Davis DR grading
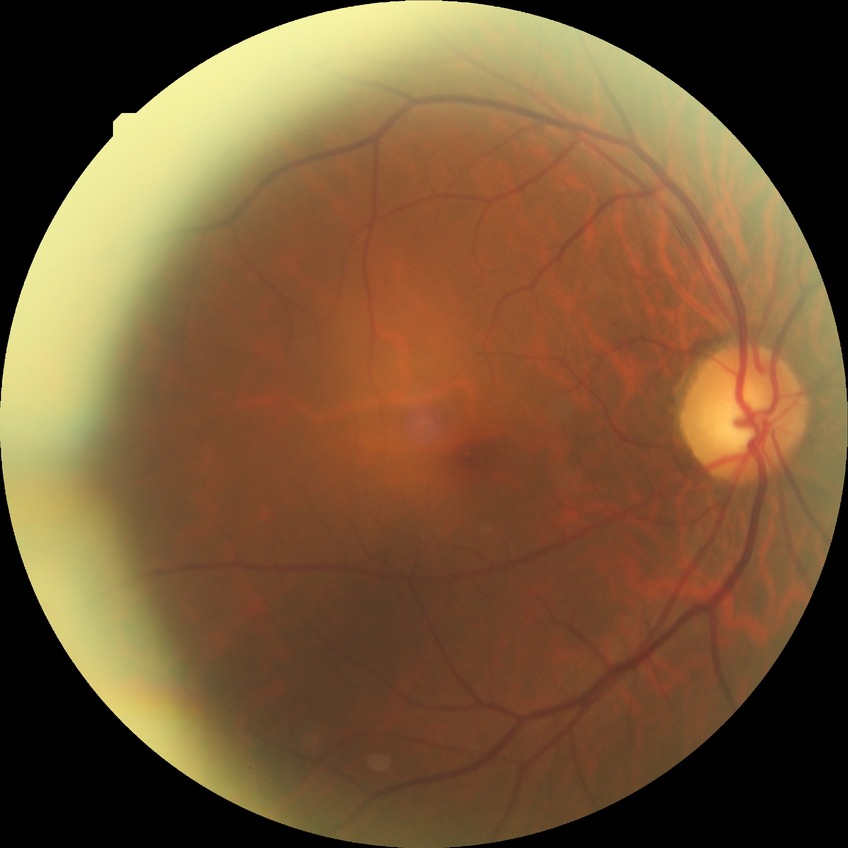 {"davis_grade": "no diabetic retinopathy (NDR)"}